Pediatric wide-field fundus photograph; 640 by 480 pixels; captured with the Clarity RetCam 3 (130° field of view):
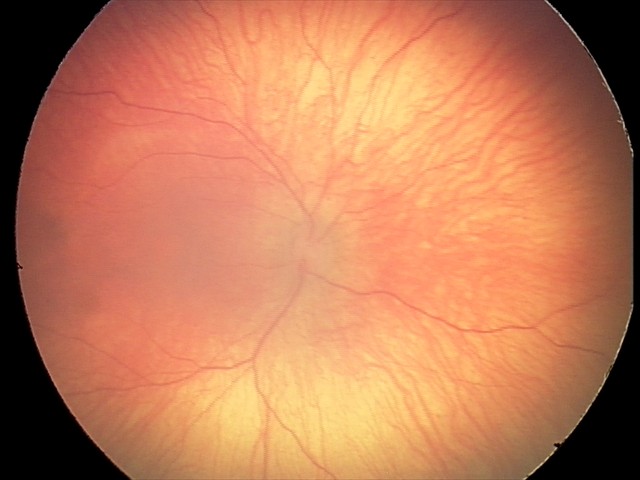
Assessment: physiological